Graded on the modified Davis scale — 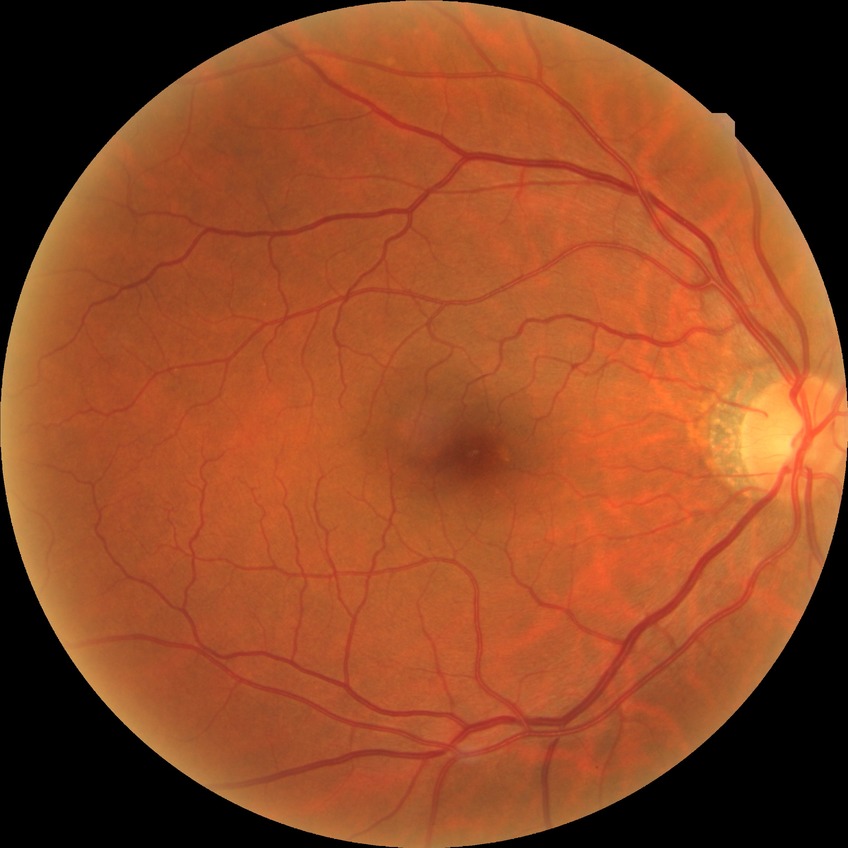

diabetic retinopathy (DR): no diabetic retinopathy (NDR).